Acquired on the Phoenix ICON · wide-field contact fundus photograph of an infant · 1240 by 1240 pixels
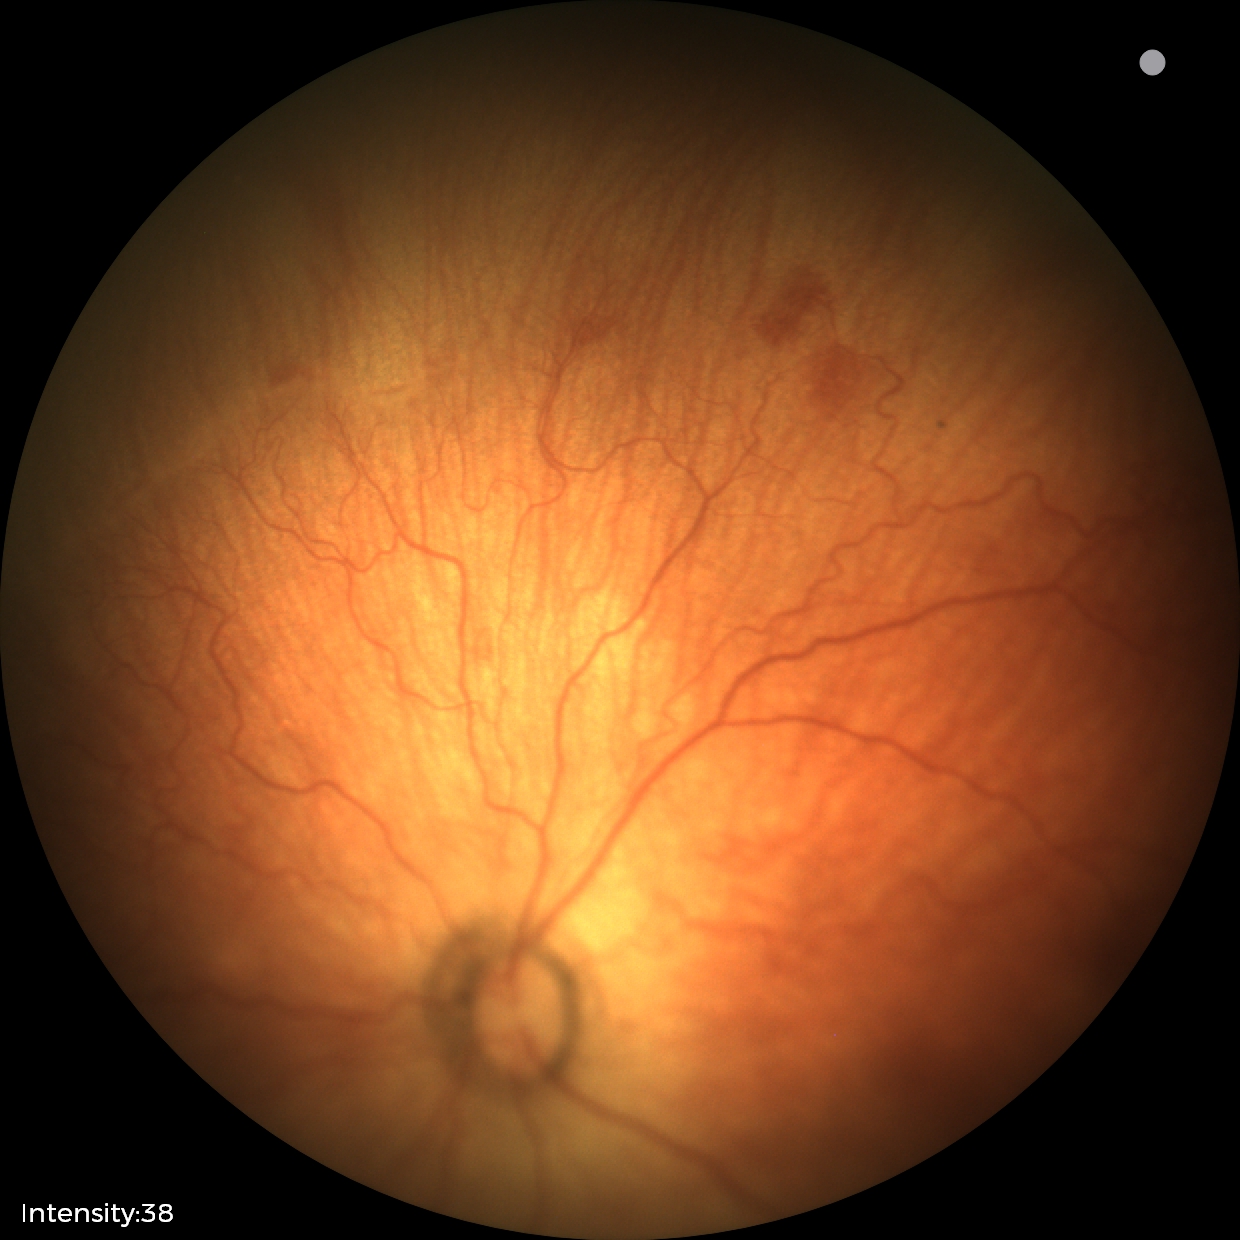 From an examination with diagnosis of retinopathy of prematurity (ROP) stage 1.